FOV: 45 degrees; color fundus photograph; 1932 by 1910 pixels.
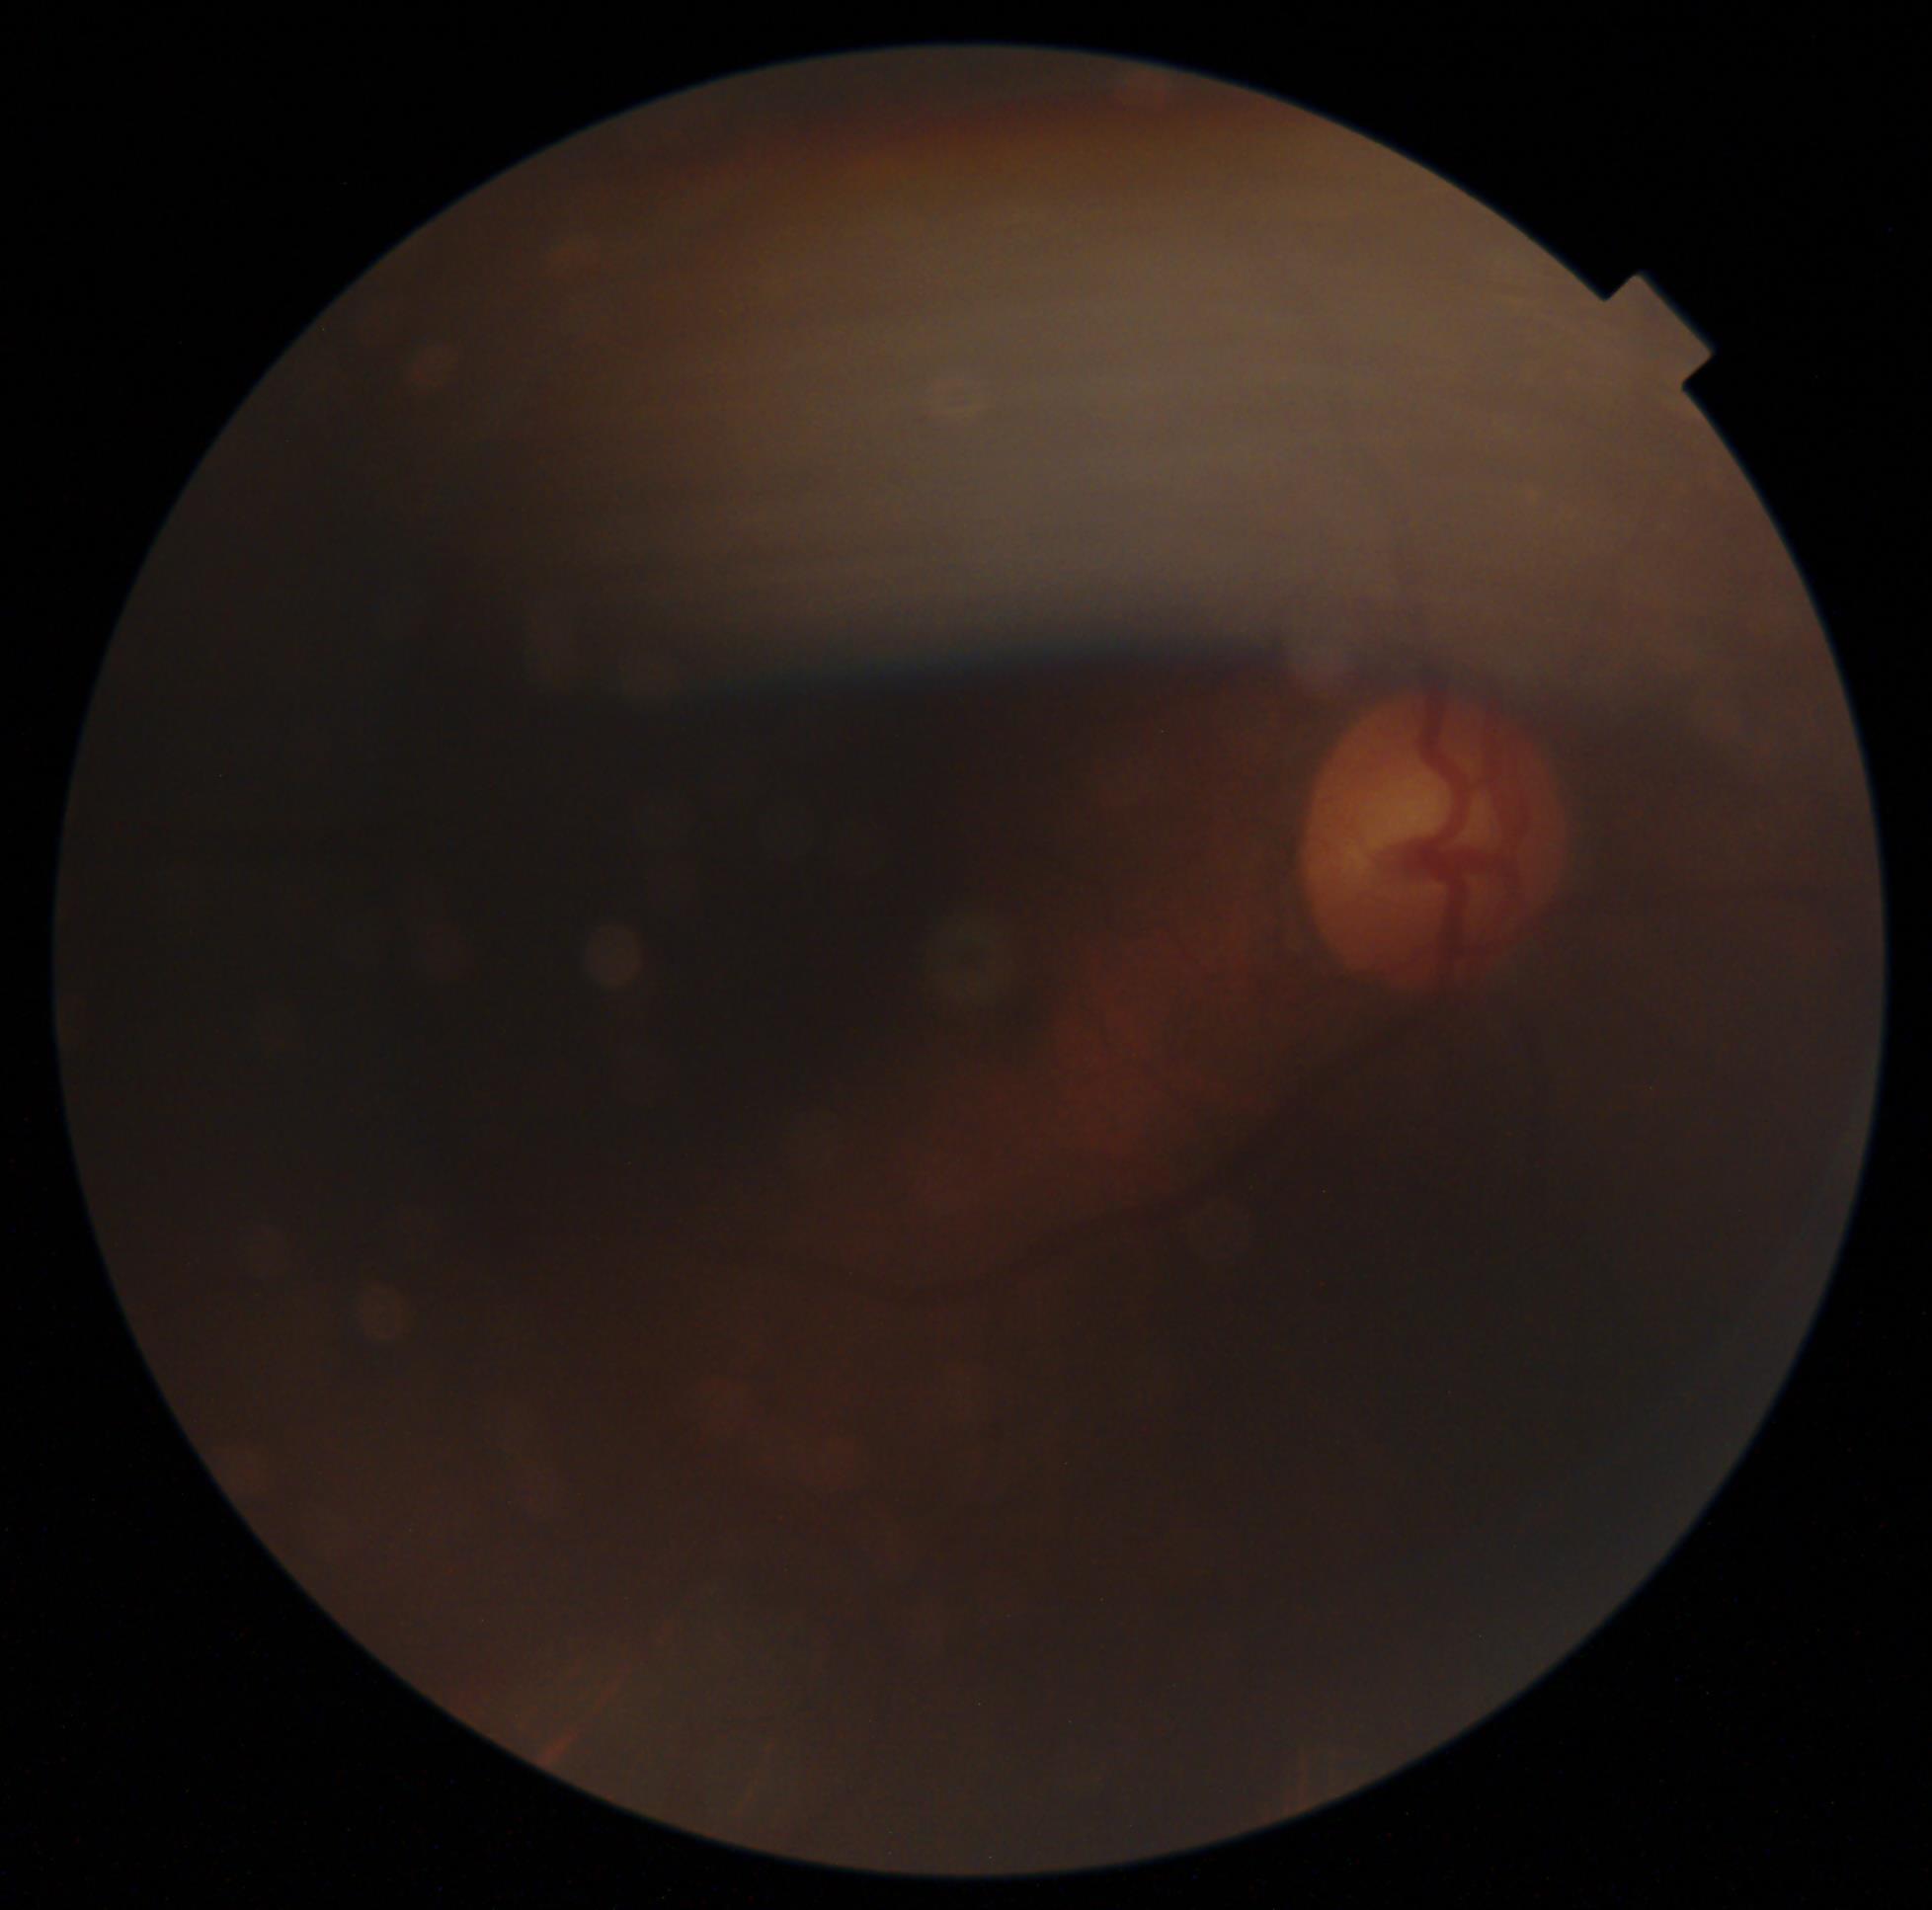
diabetic retinopathy (DR): ungradable | image quality: below grading threshold.